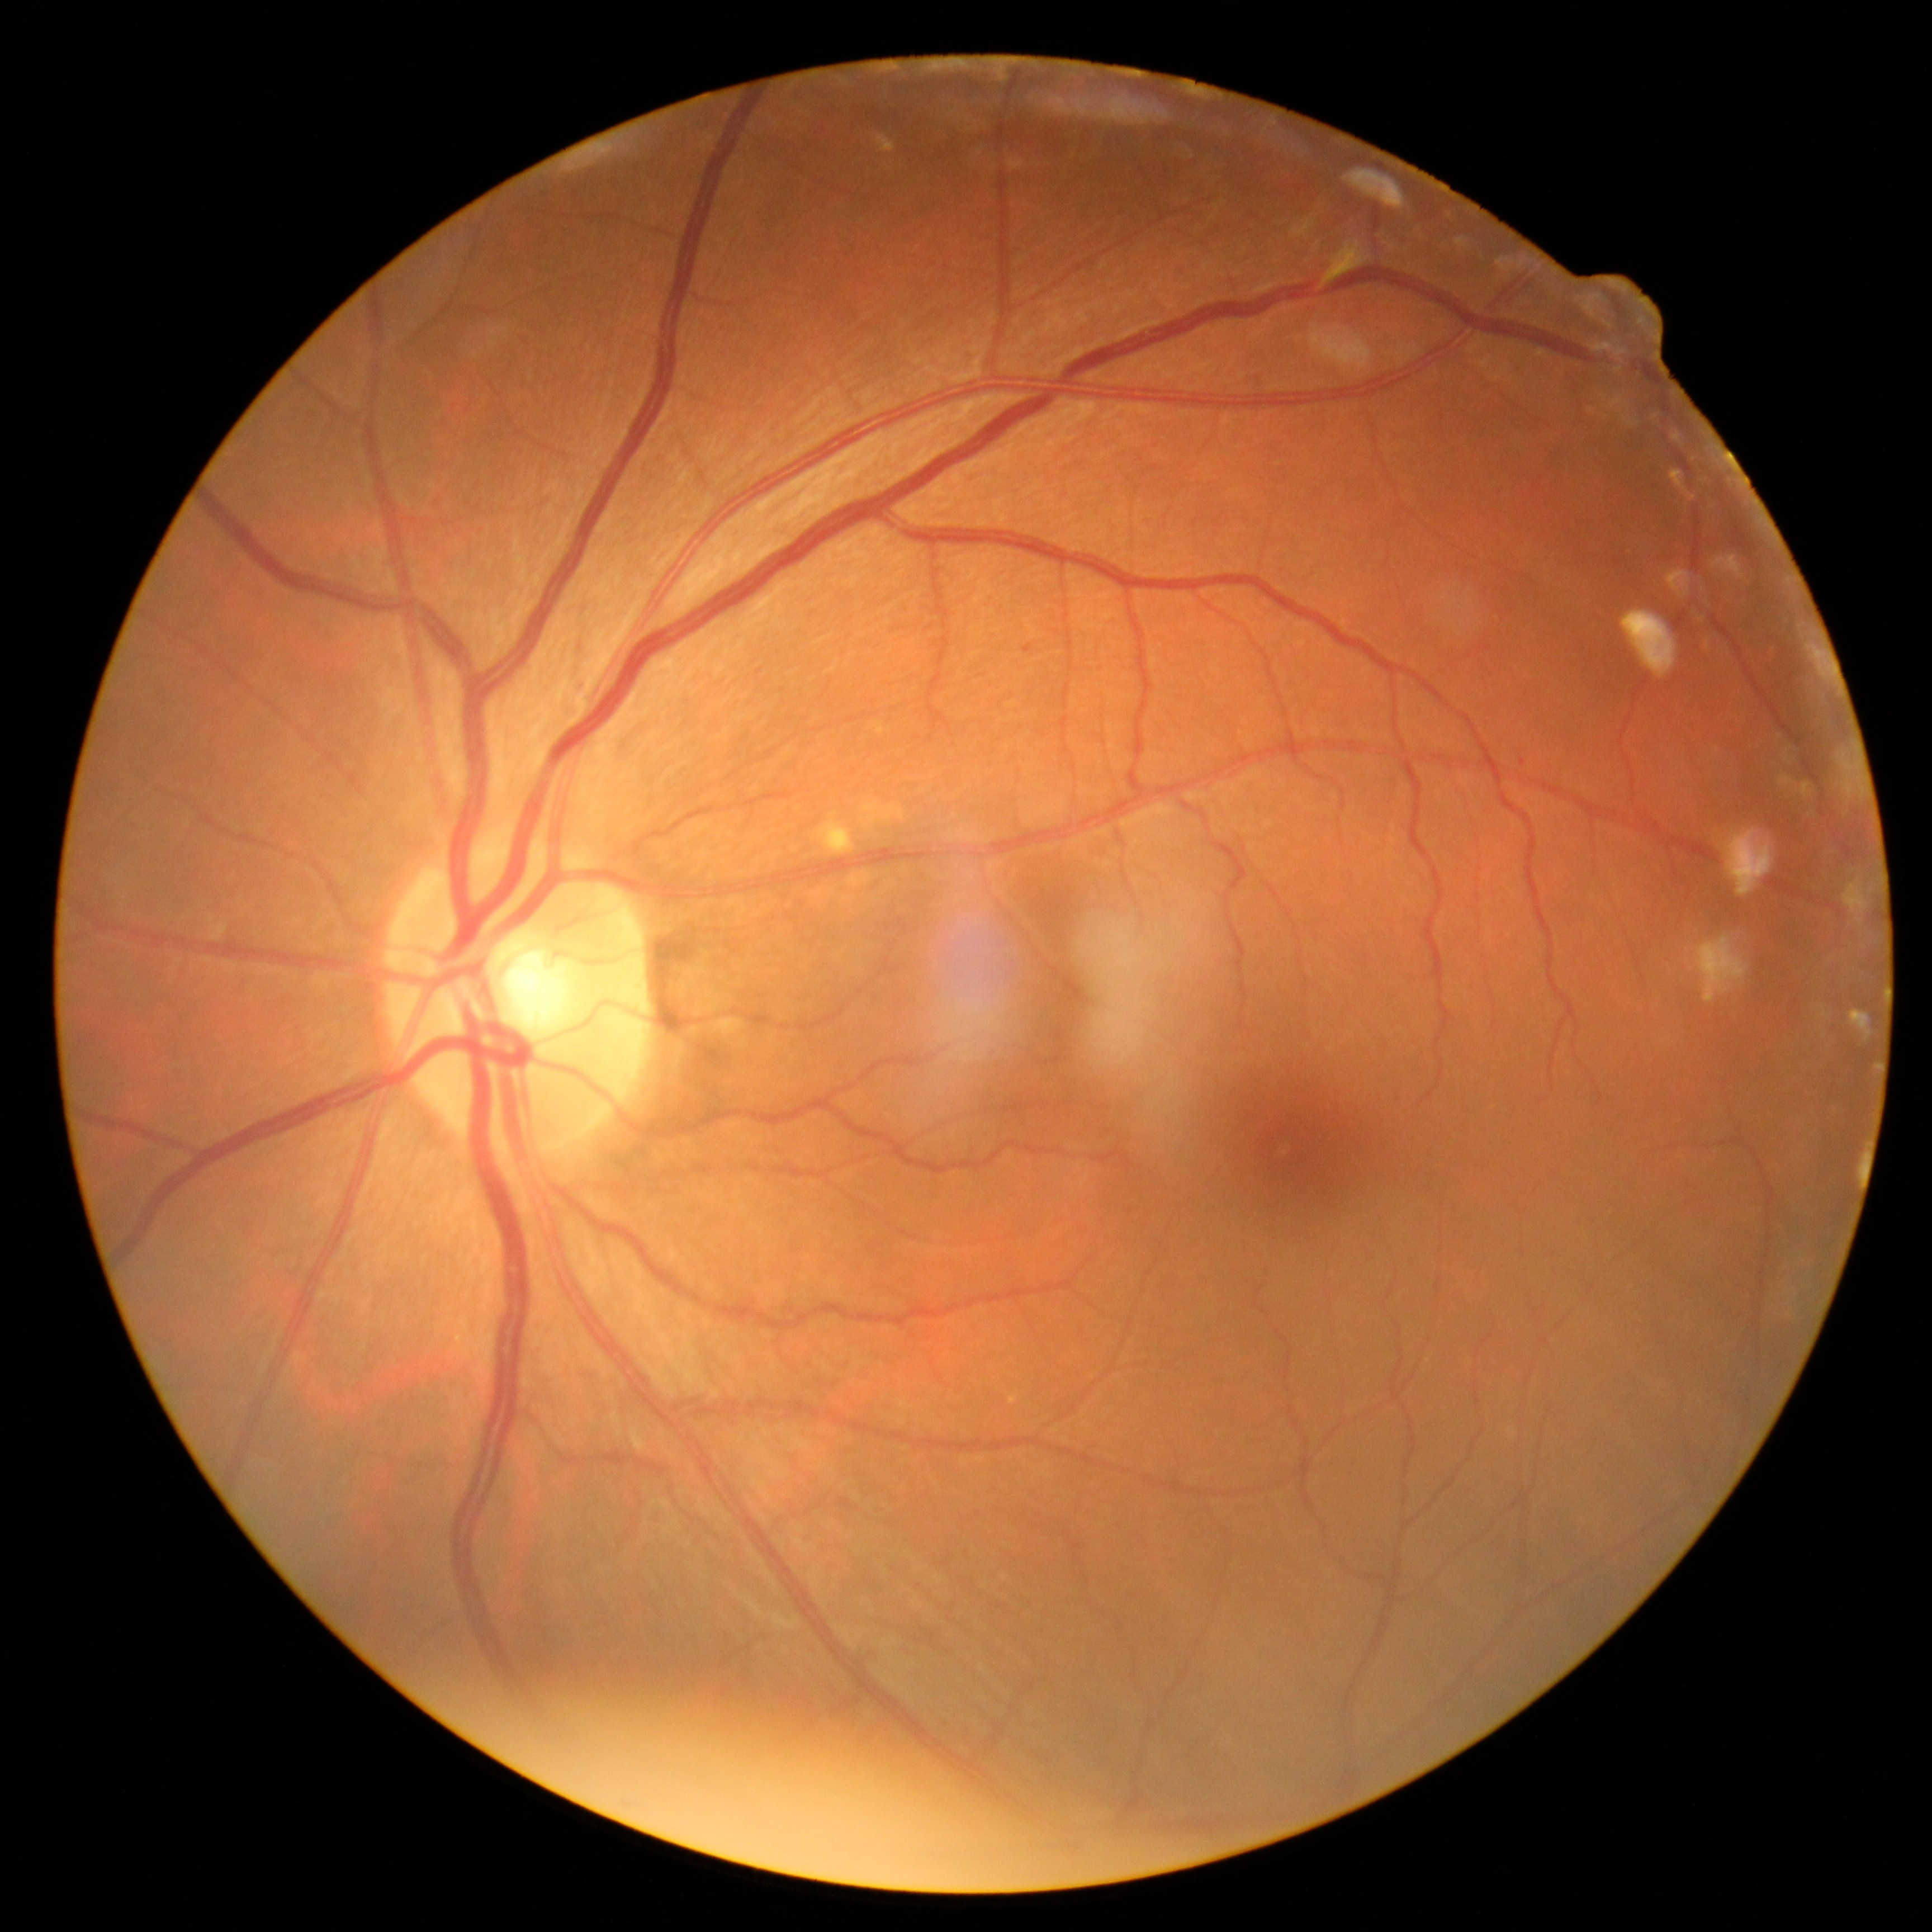
Findings:
– DR severity — mild NPDR (grade 1)